Wide-field contact fundus photograph of an infant; 1440 x 1080 pixels
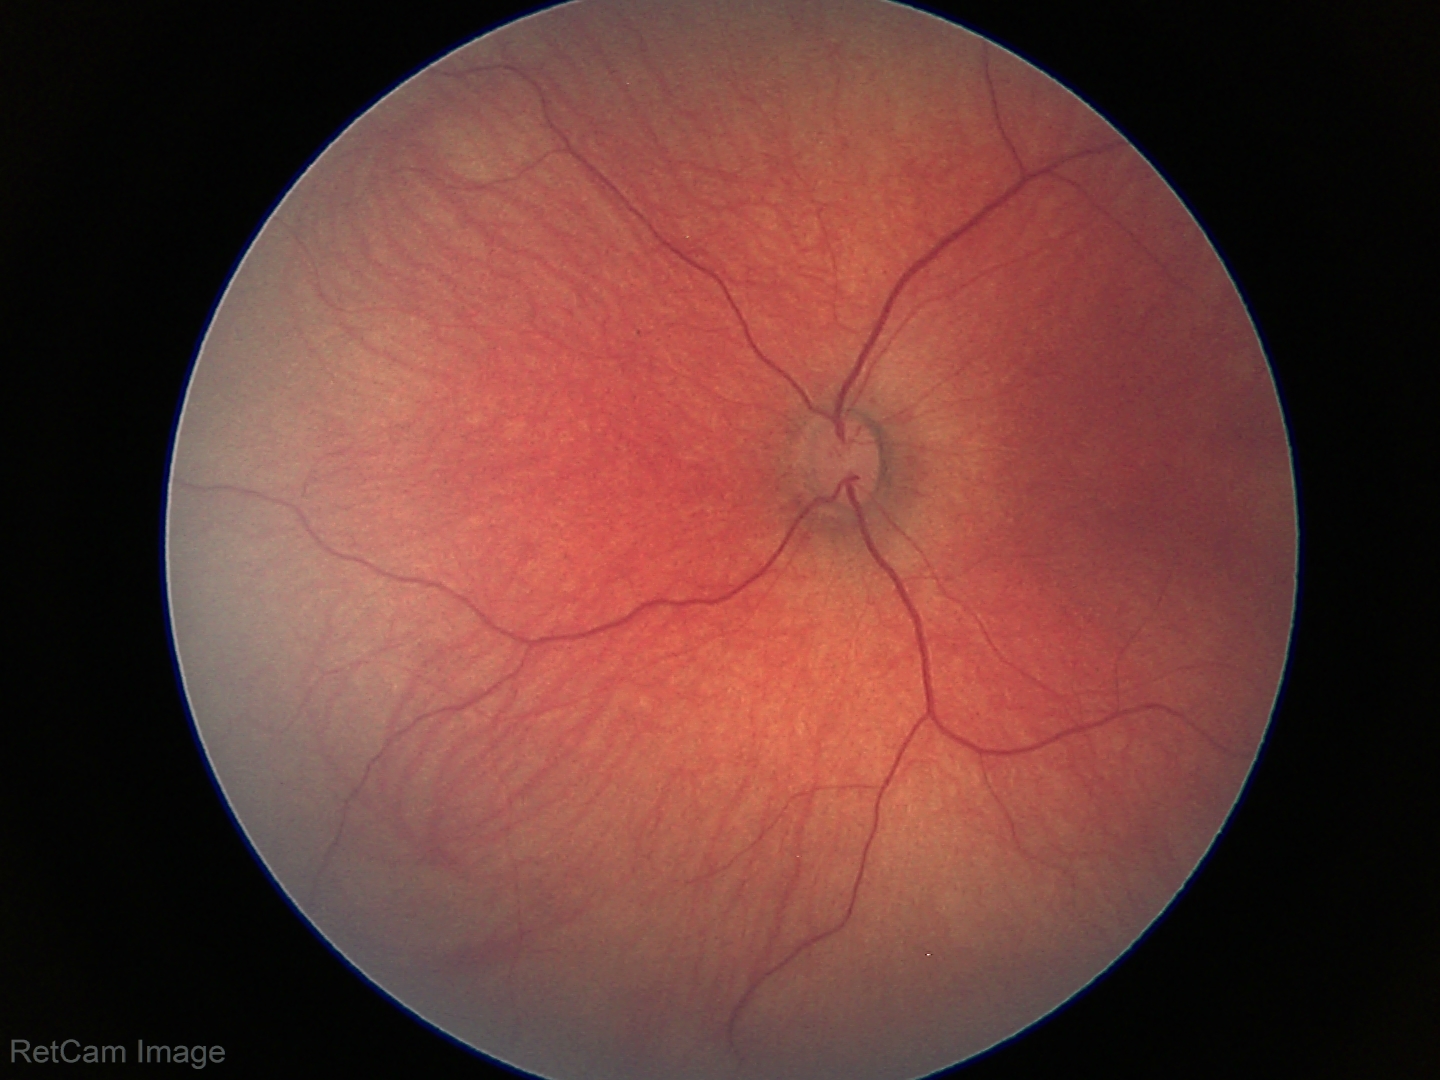
Q: What was the screening finding?
A: physiological retinal finding